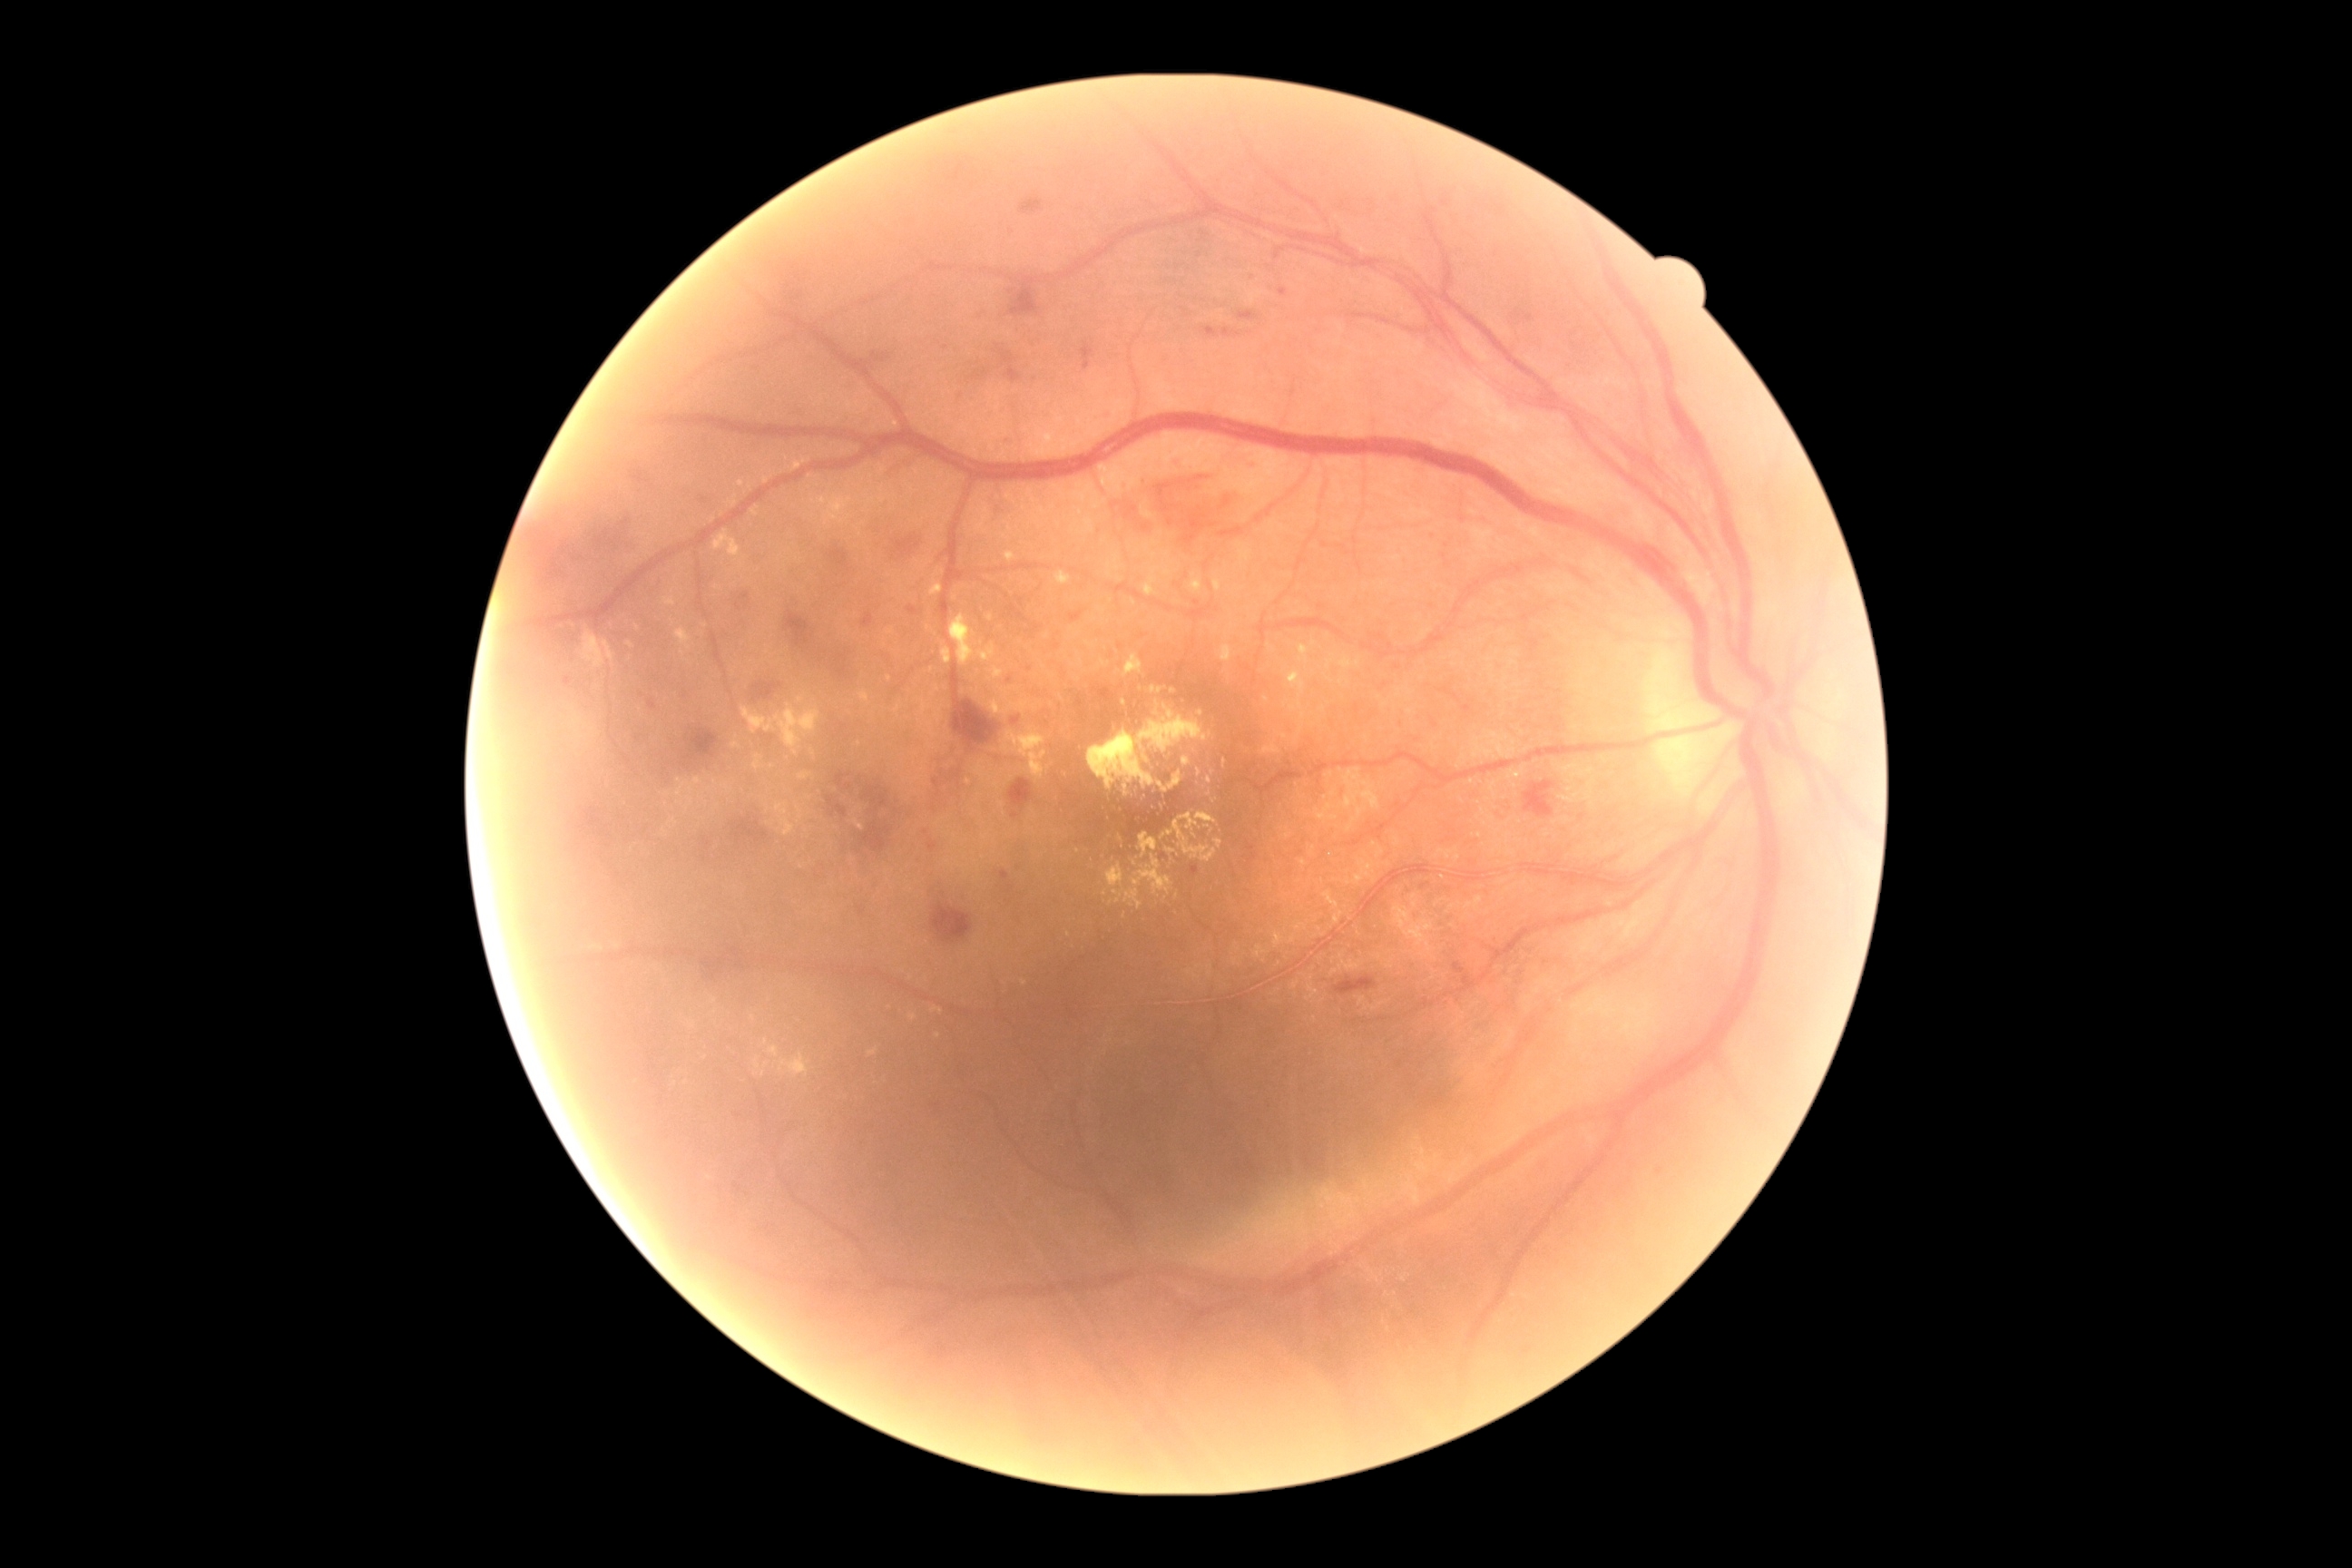

Diabetic retinopathy grade: 2/4
Selected lesions:
soft exudates: absent
hemorrhages (more not shown): (734,589,754,614), (868,353,892,368), (565,678,571,687), (507,493,634,616), (1010,279,1039,317), (928,841,937,854), (932,903,972,943), (632,471,643,484), (1019,199,1044,215), (925,752,972,816), (1001,351,1023,382), (858,906,865,916), (718,805,767,856)
Smaller hemorrhages around <point>945, 348</point>
hard exudates (more not shown): (602,640,614,667), (868,1048,879,1057), (1113,888,1142,908), (992,667,1003,680), (1220,645,1233,663), (1088,705,1211,790), (756,1057,761,1070), (950,614,977,667), (1297,701,1302,710), (1279,957,1291,972), (1302,712,1306,720)
Smaller hard exudates around <point>1106, 894</point>, <point>931, 726</point>, <point>1208, 781</point>, <point>763, 1074</point>, <point>801, 701</point>, <point>741, 565</point>, <point>1195, 836</point>
microaneurysms (more not shown): (1204,328,1219,340), (1525,315,1534,322), (1415,883,1429,894), (1248,466,1255,475), (1398,720,1404,729), (1001,870,1010,881), (1279,288,1288,297), (1275,250,1286,260), (1222,328,1240,338), (1193,865,1206,879), (997,431,1014,455), (932,1095,948,1119), (1239,311,1259,322)
Smaller microaneurysms around <point>1011, 680</point>, <point>1165, 856</point>, <point>1012, 888</point>, <point>1518, 314</point>